2048x1536px; FOV: 45 degrees:
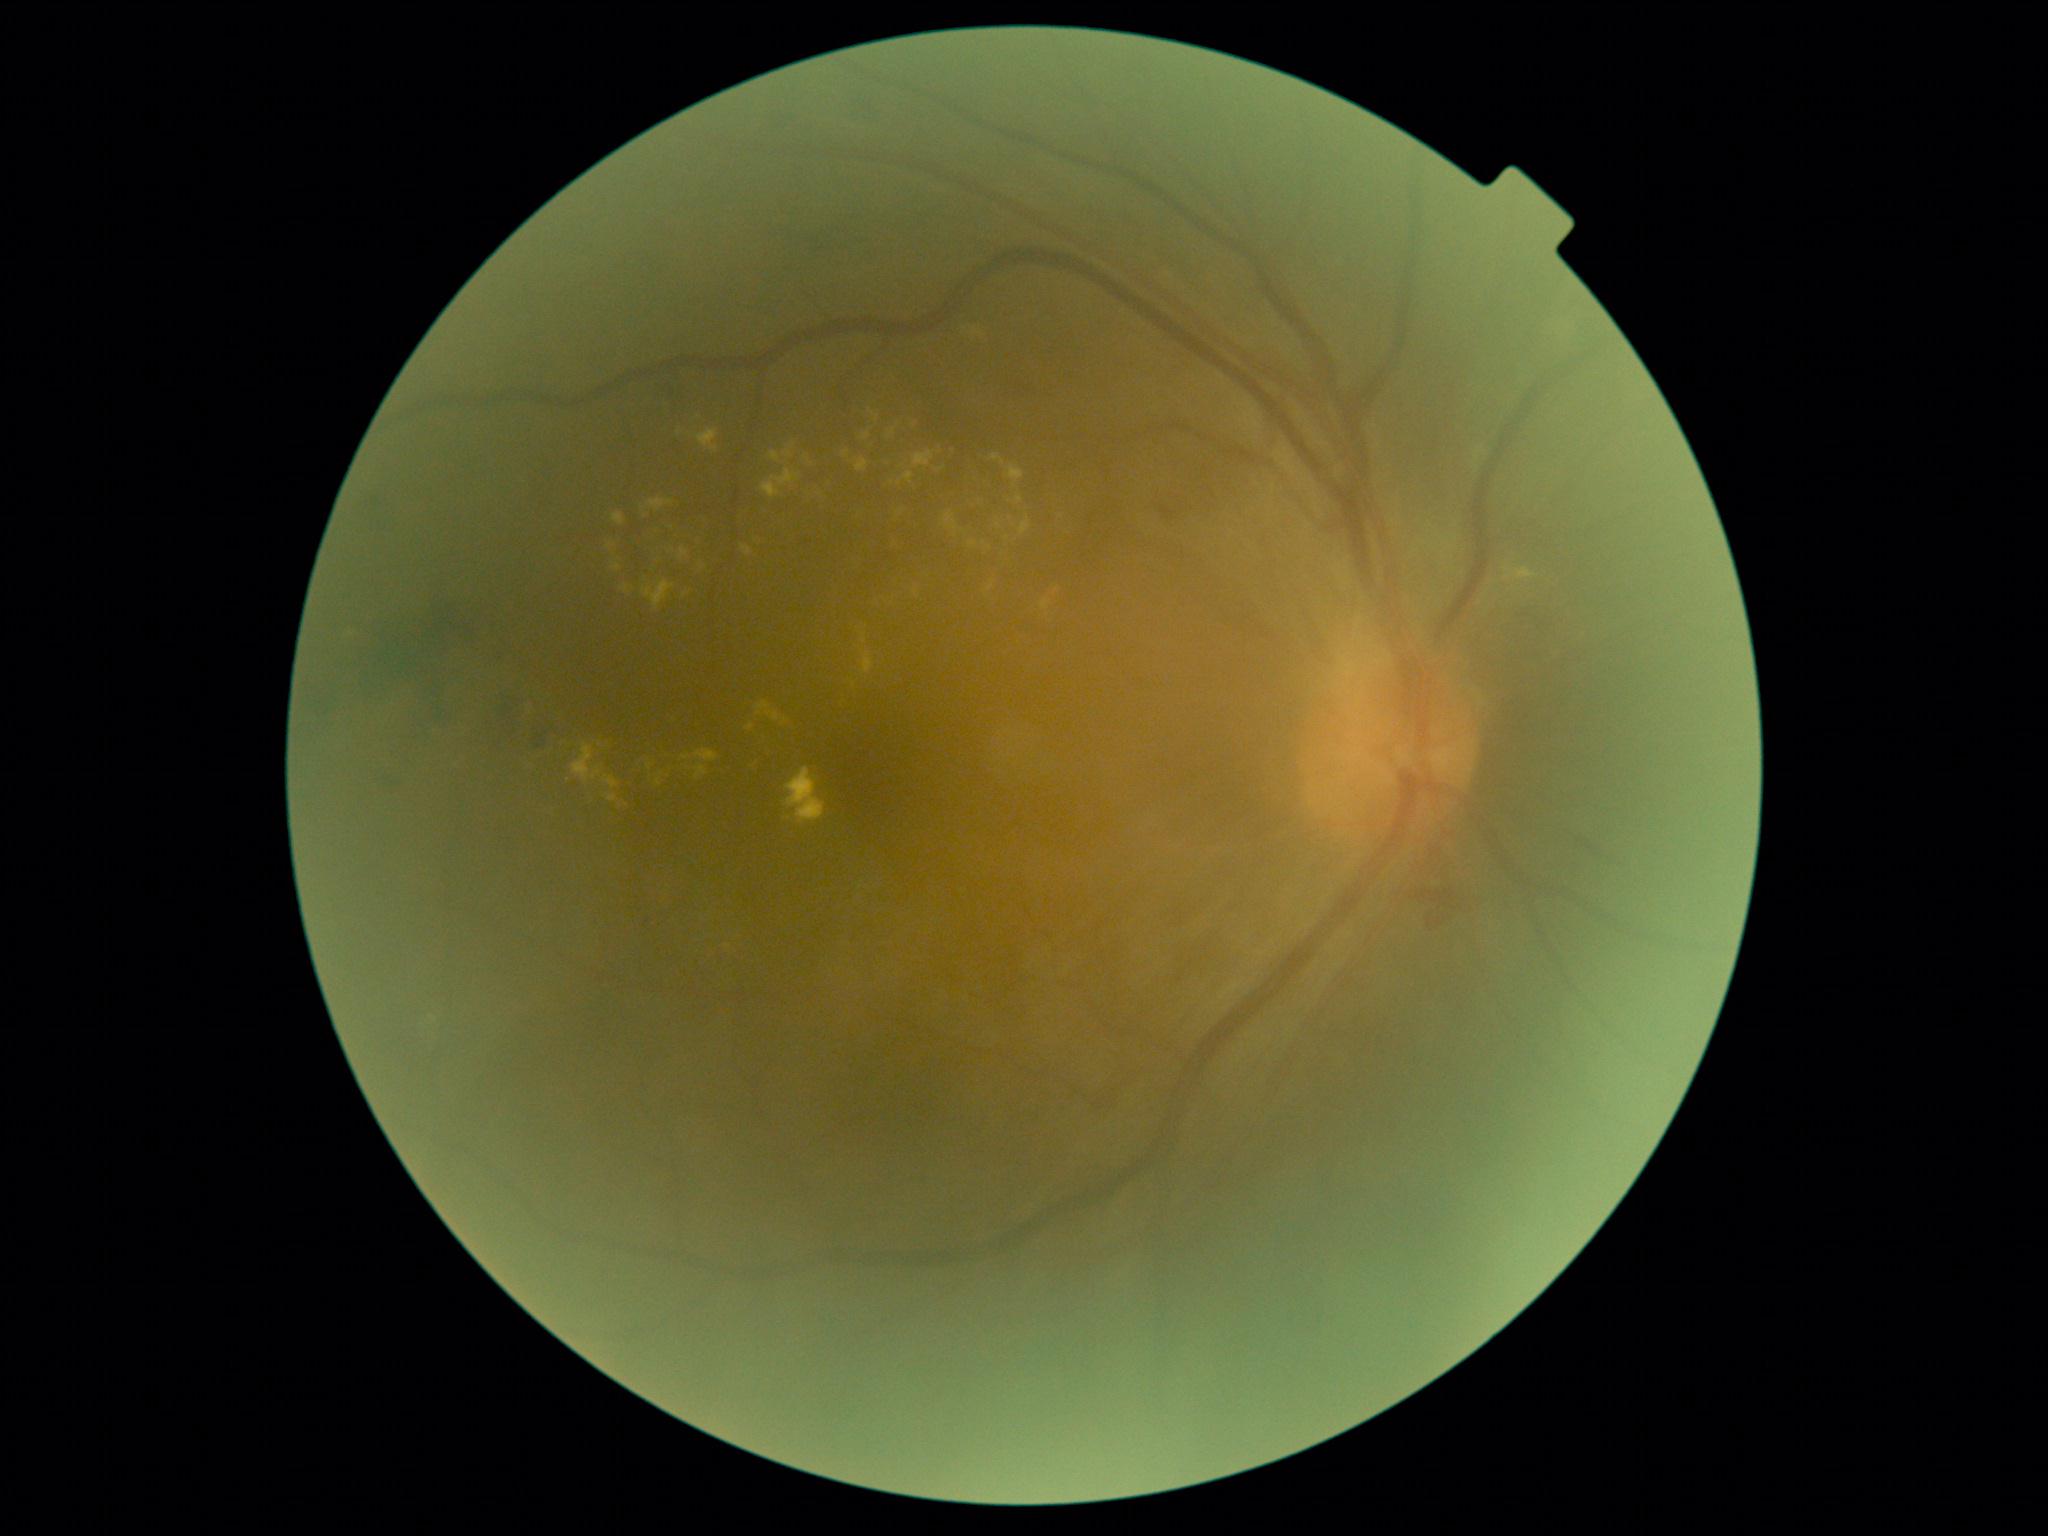

Diabetic retinopathy (DR): moderate NPDR (grade 2).